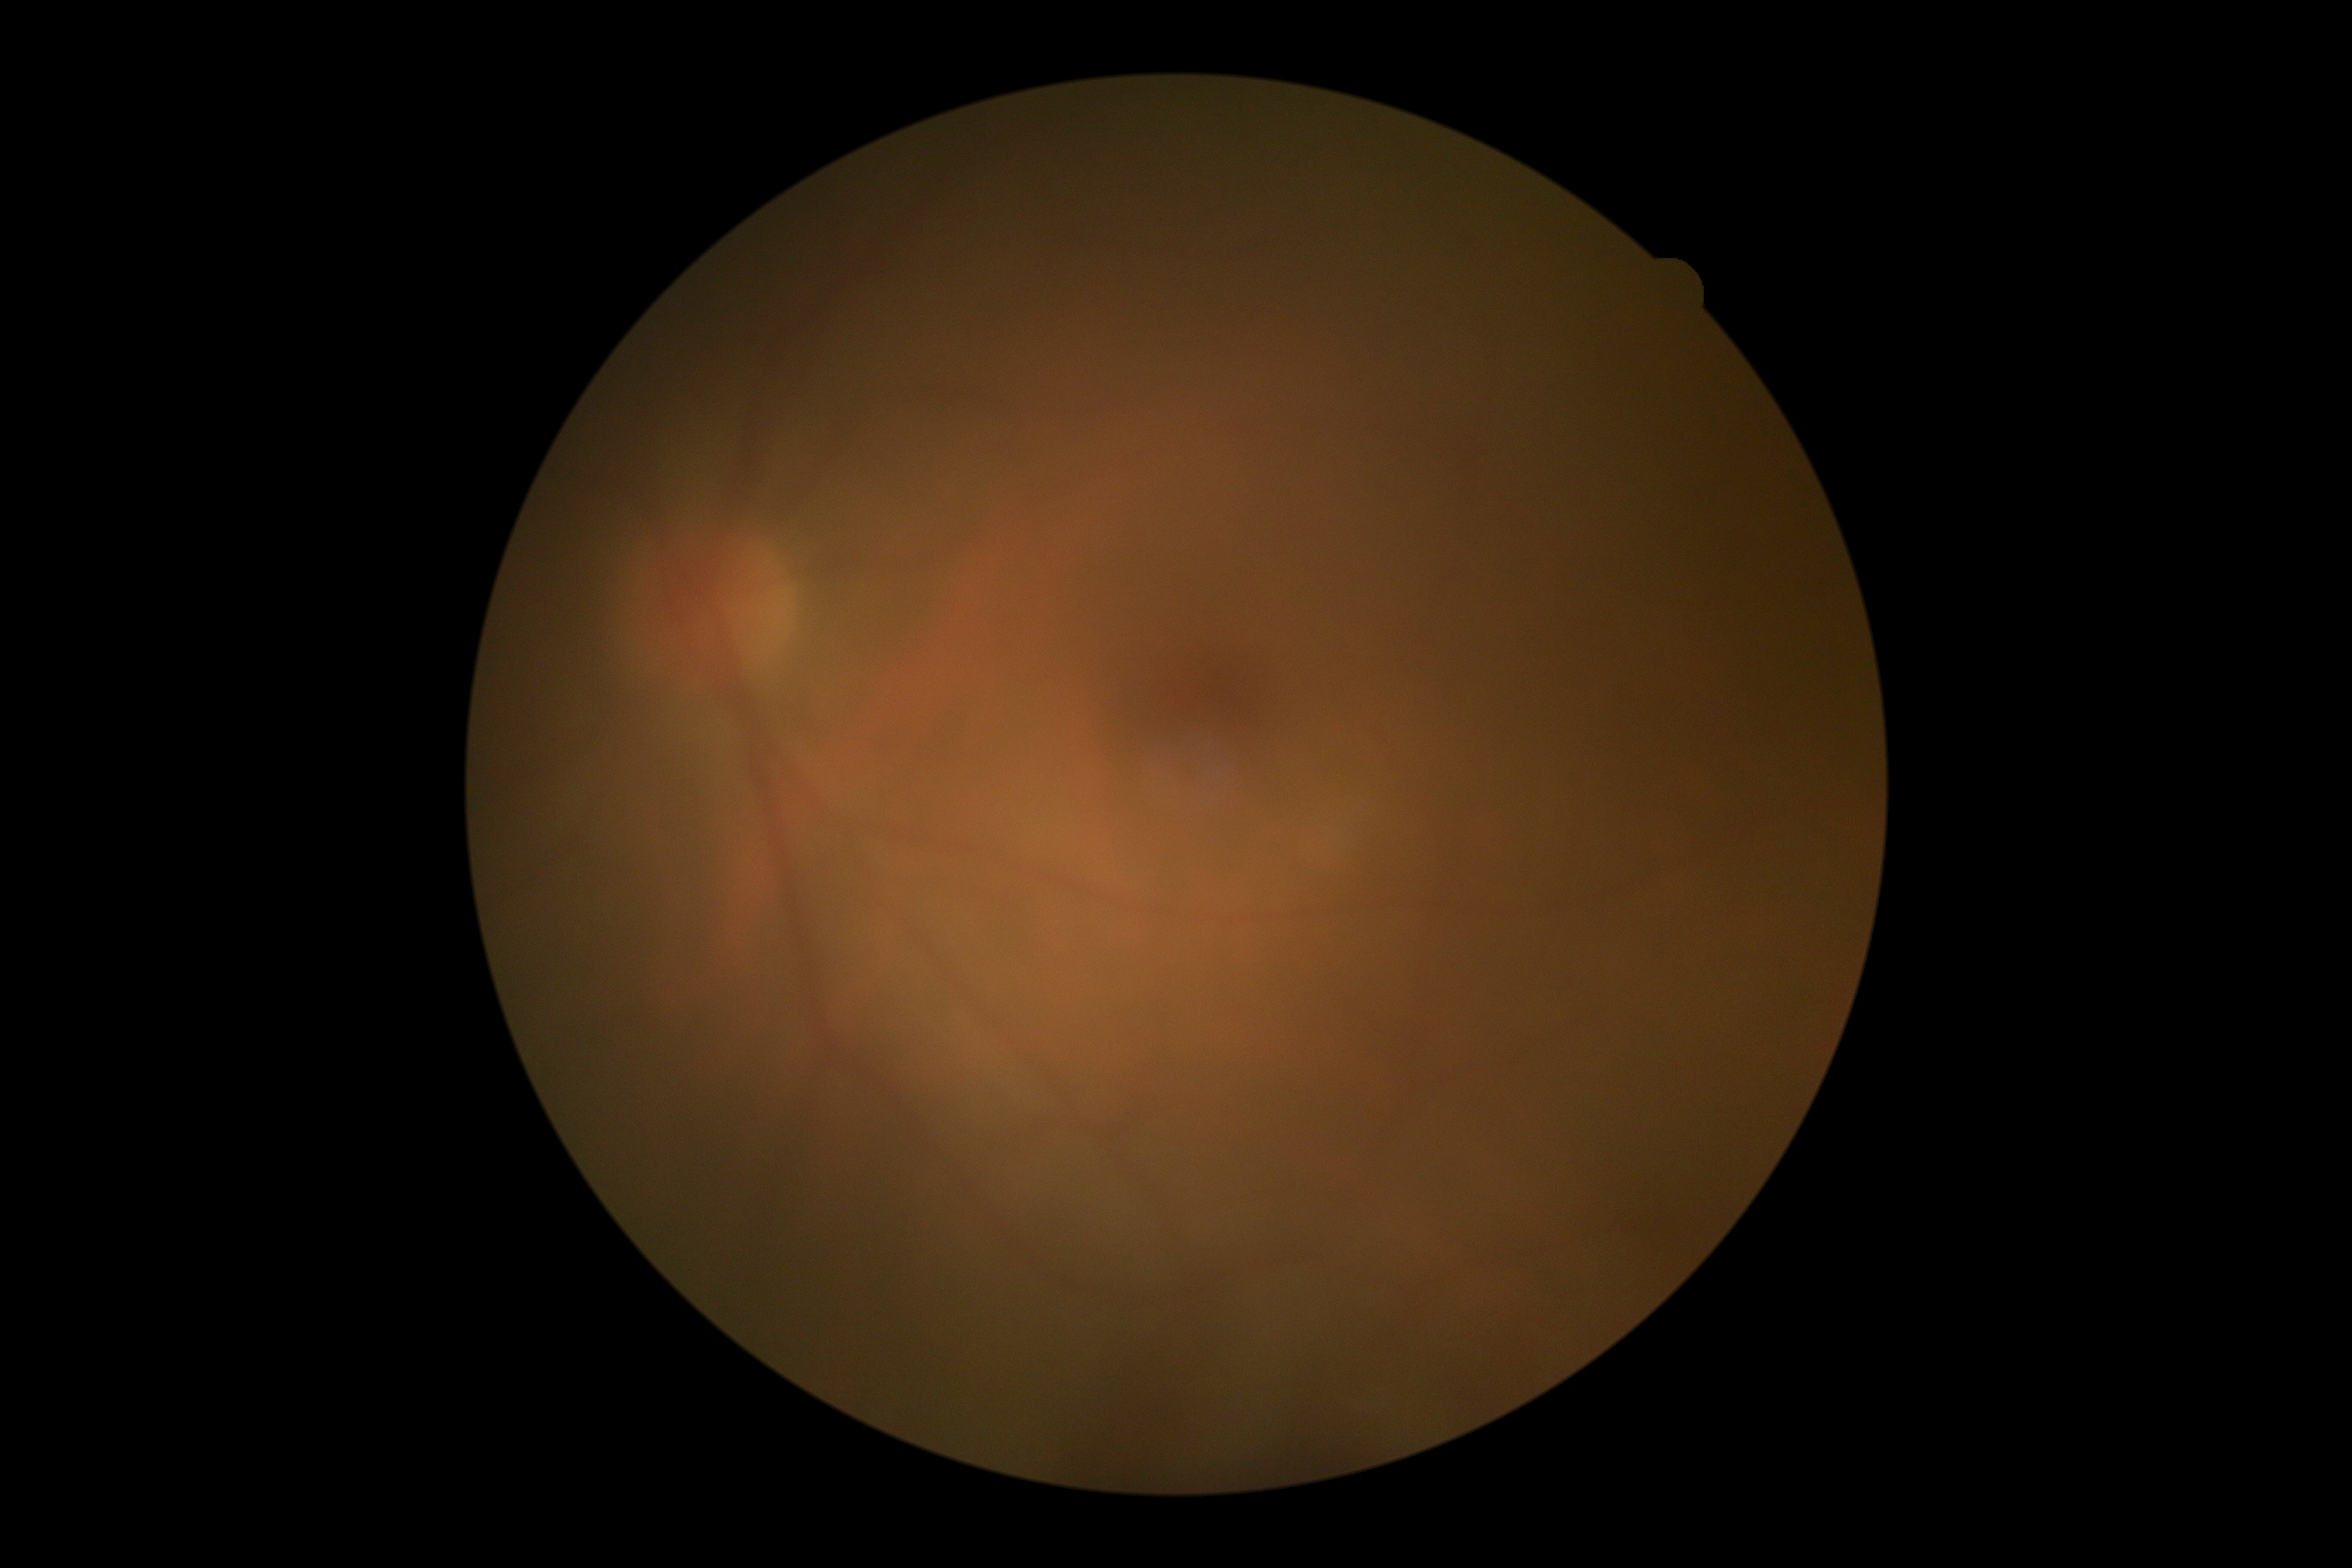 DR impression = no DR findings
diabetic retinopathy (DR) = 0